No pharmacologic dilation, 45-degree field of view
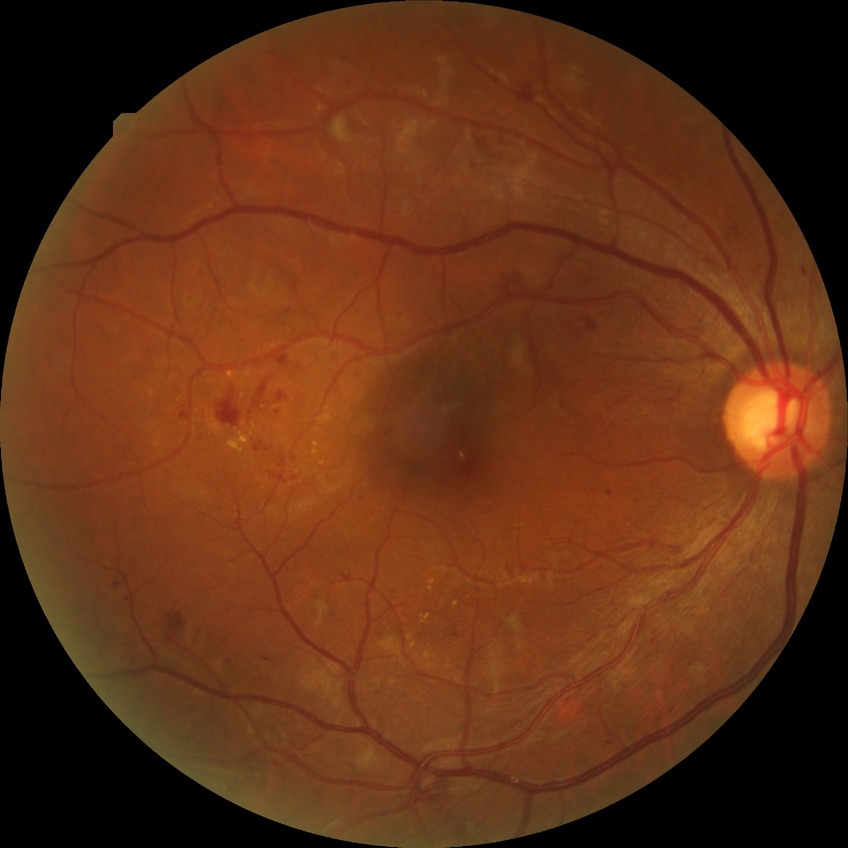
Diabetic retinopathy (DR) is PPDR (pre-proliferative diabetic retinopathy).